Macula-centered.
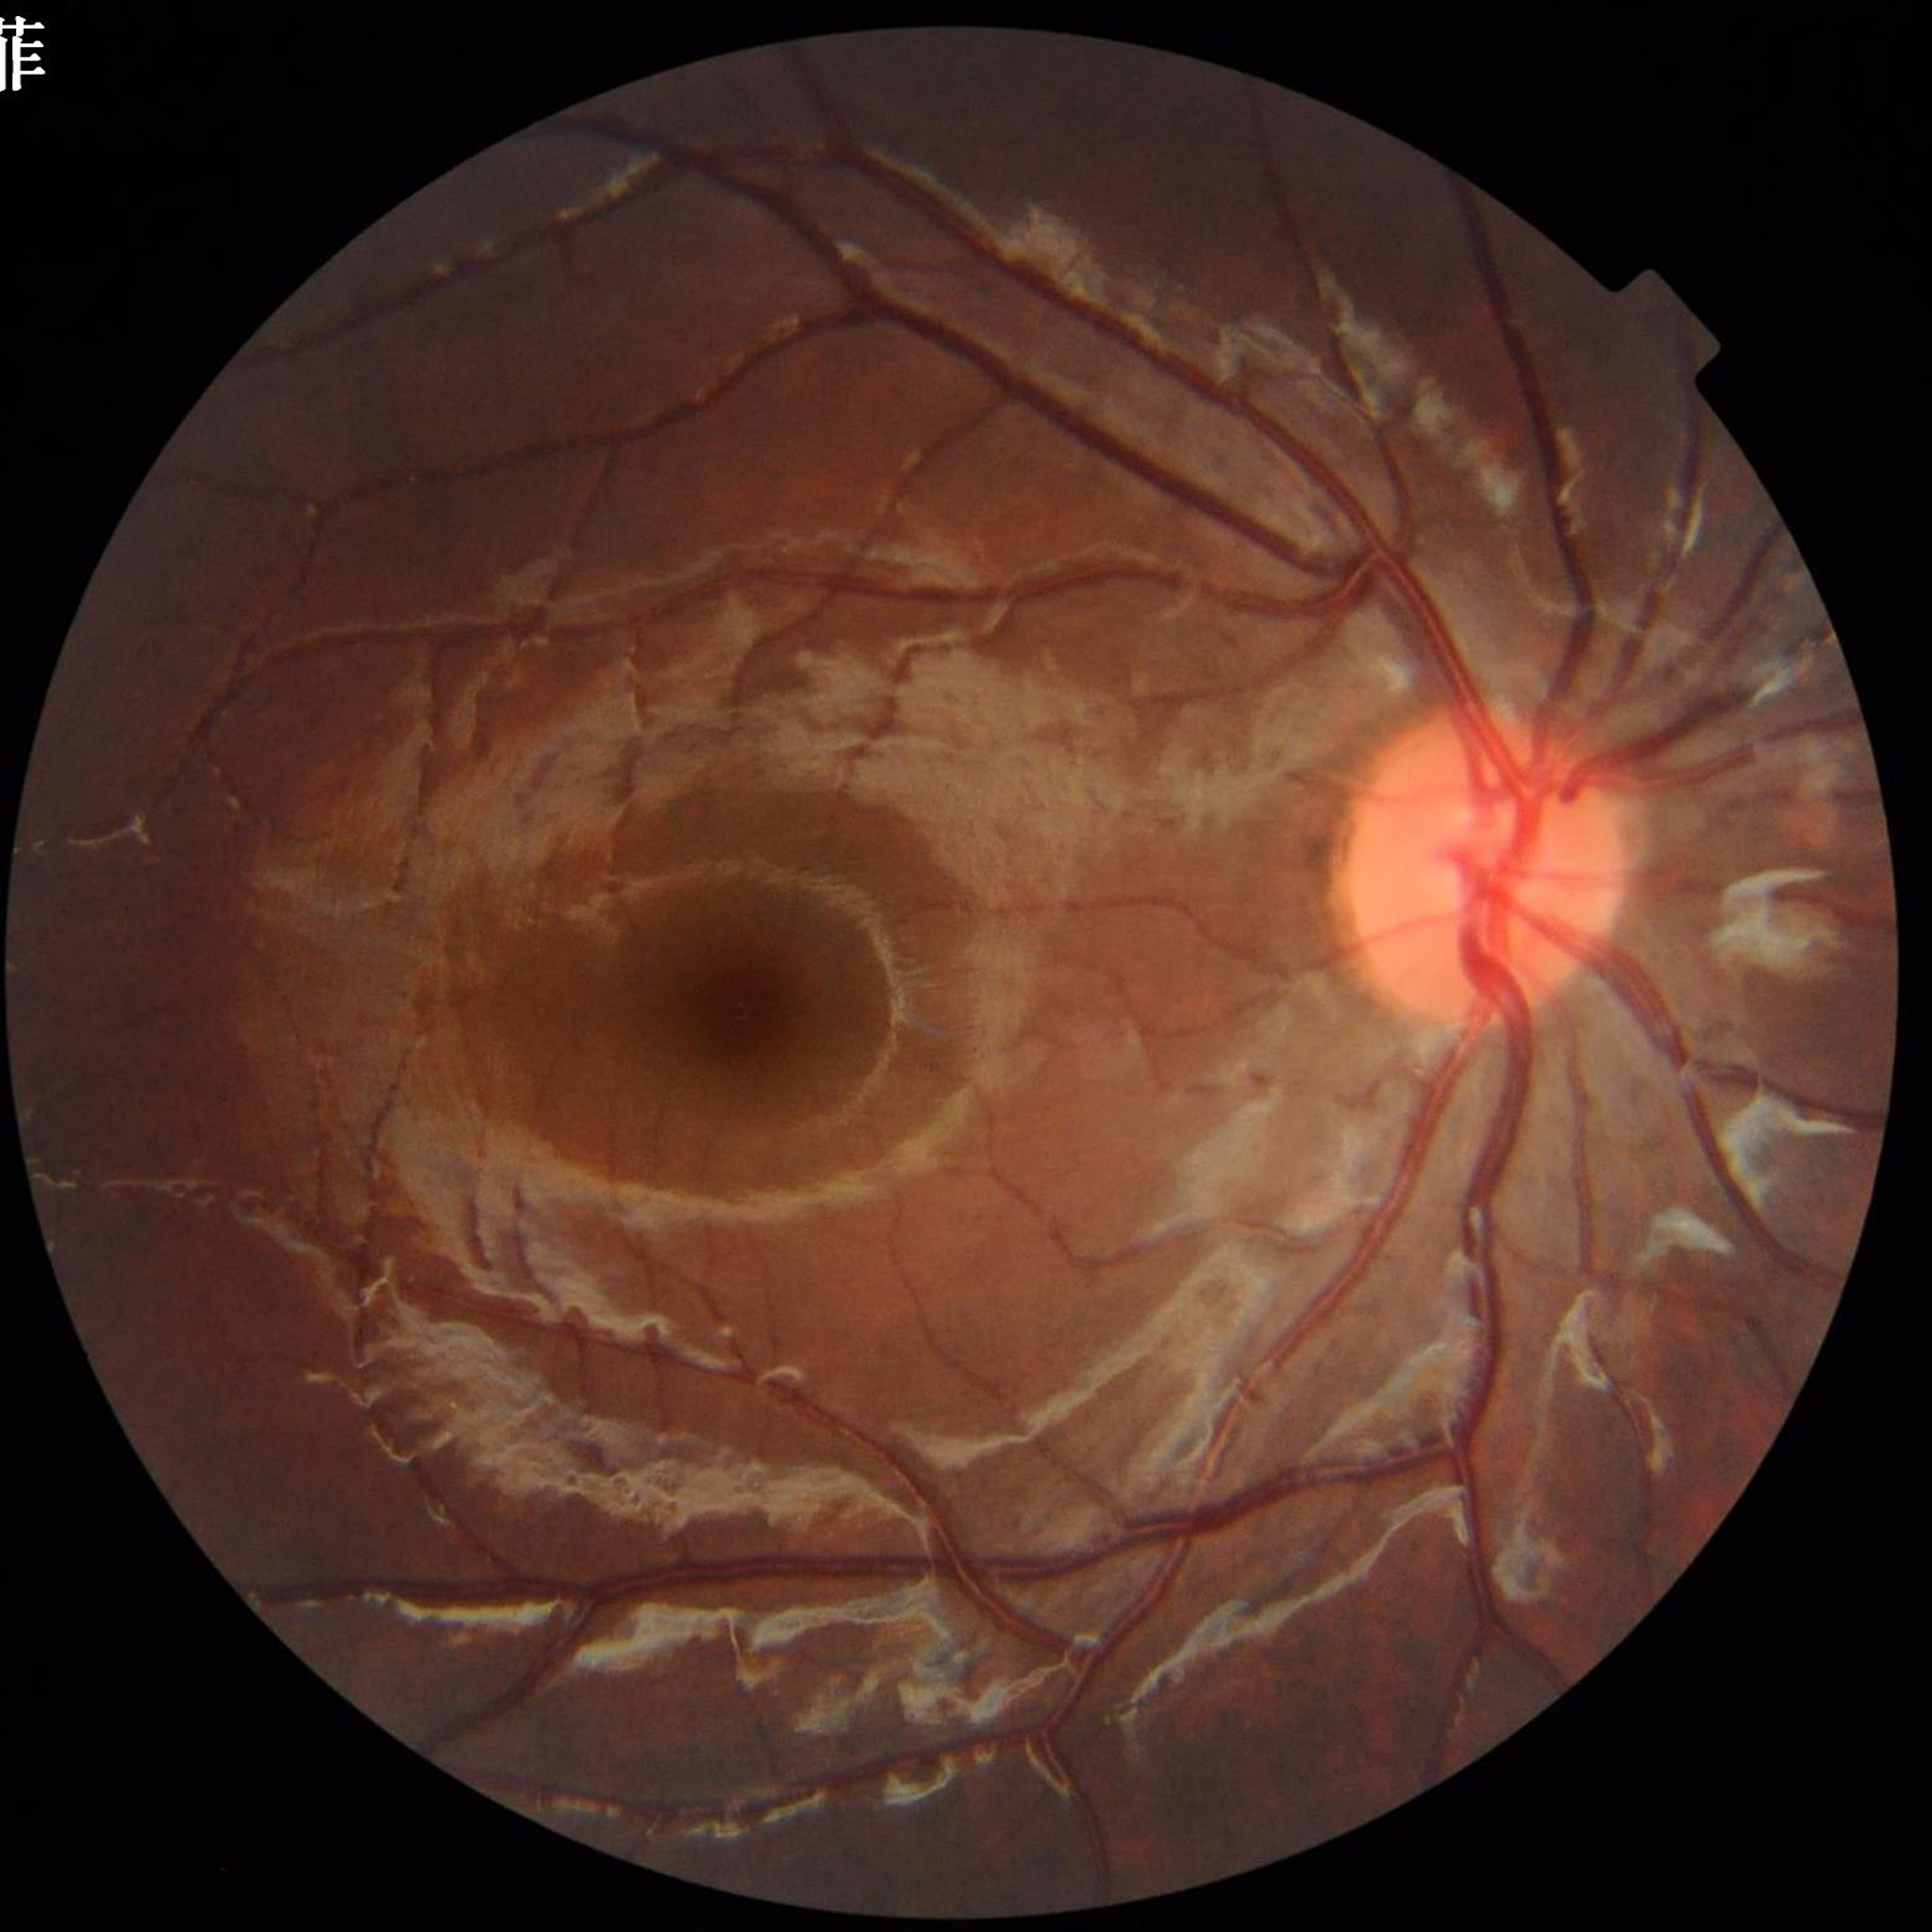
diagnosis: no AMD, DR, or glaucoma
image_quality: adequate